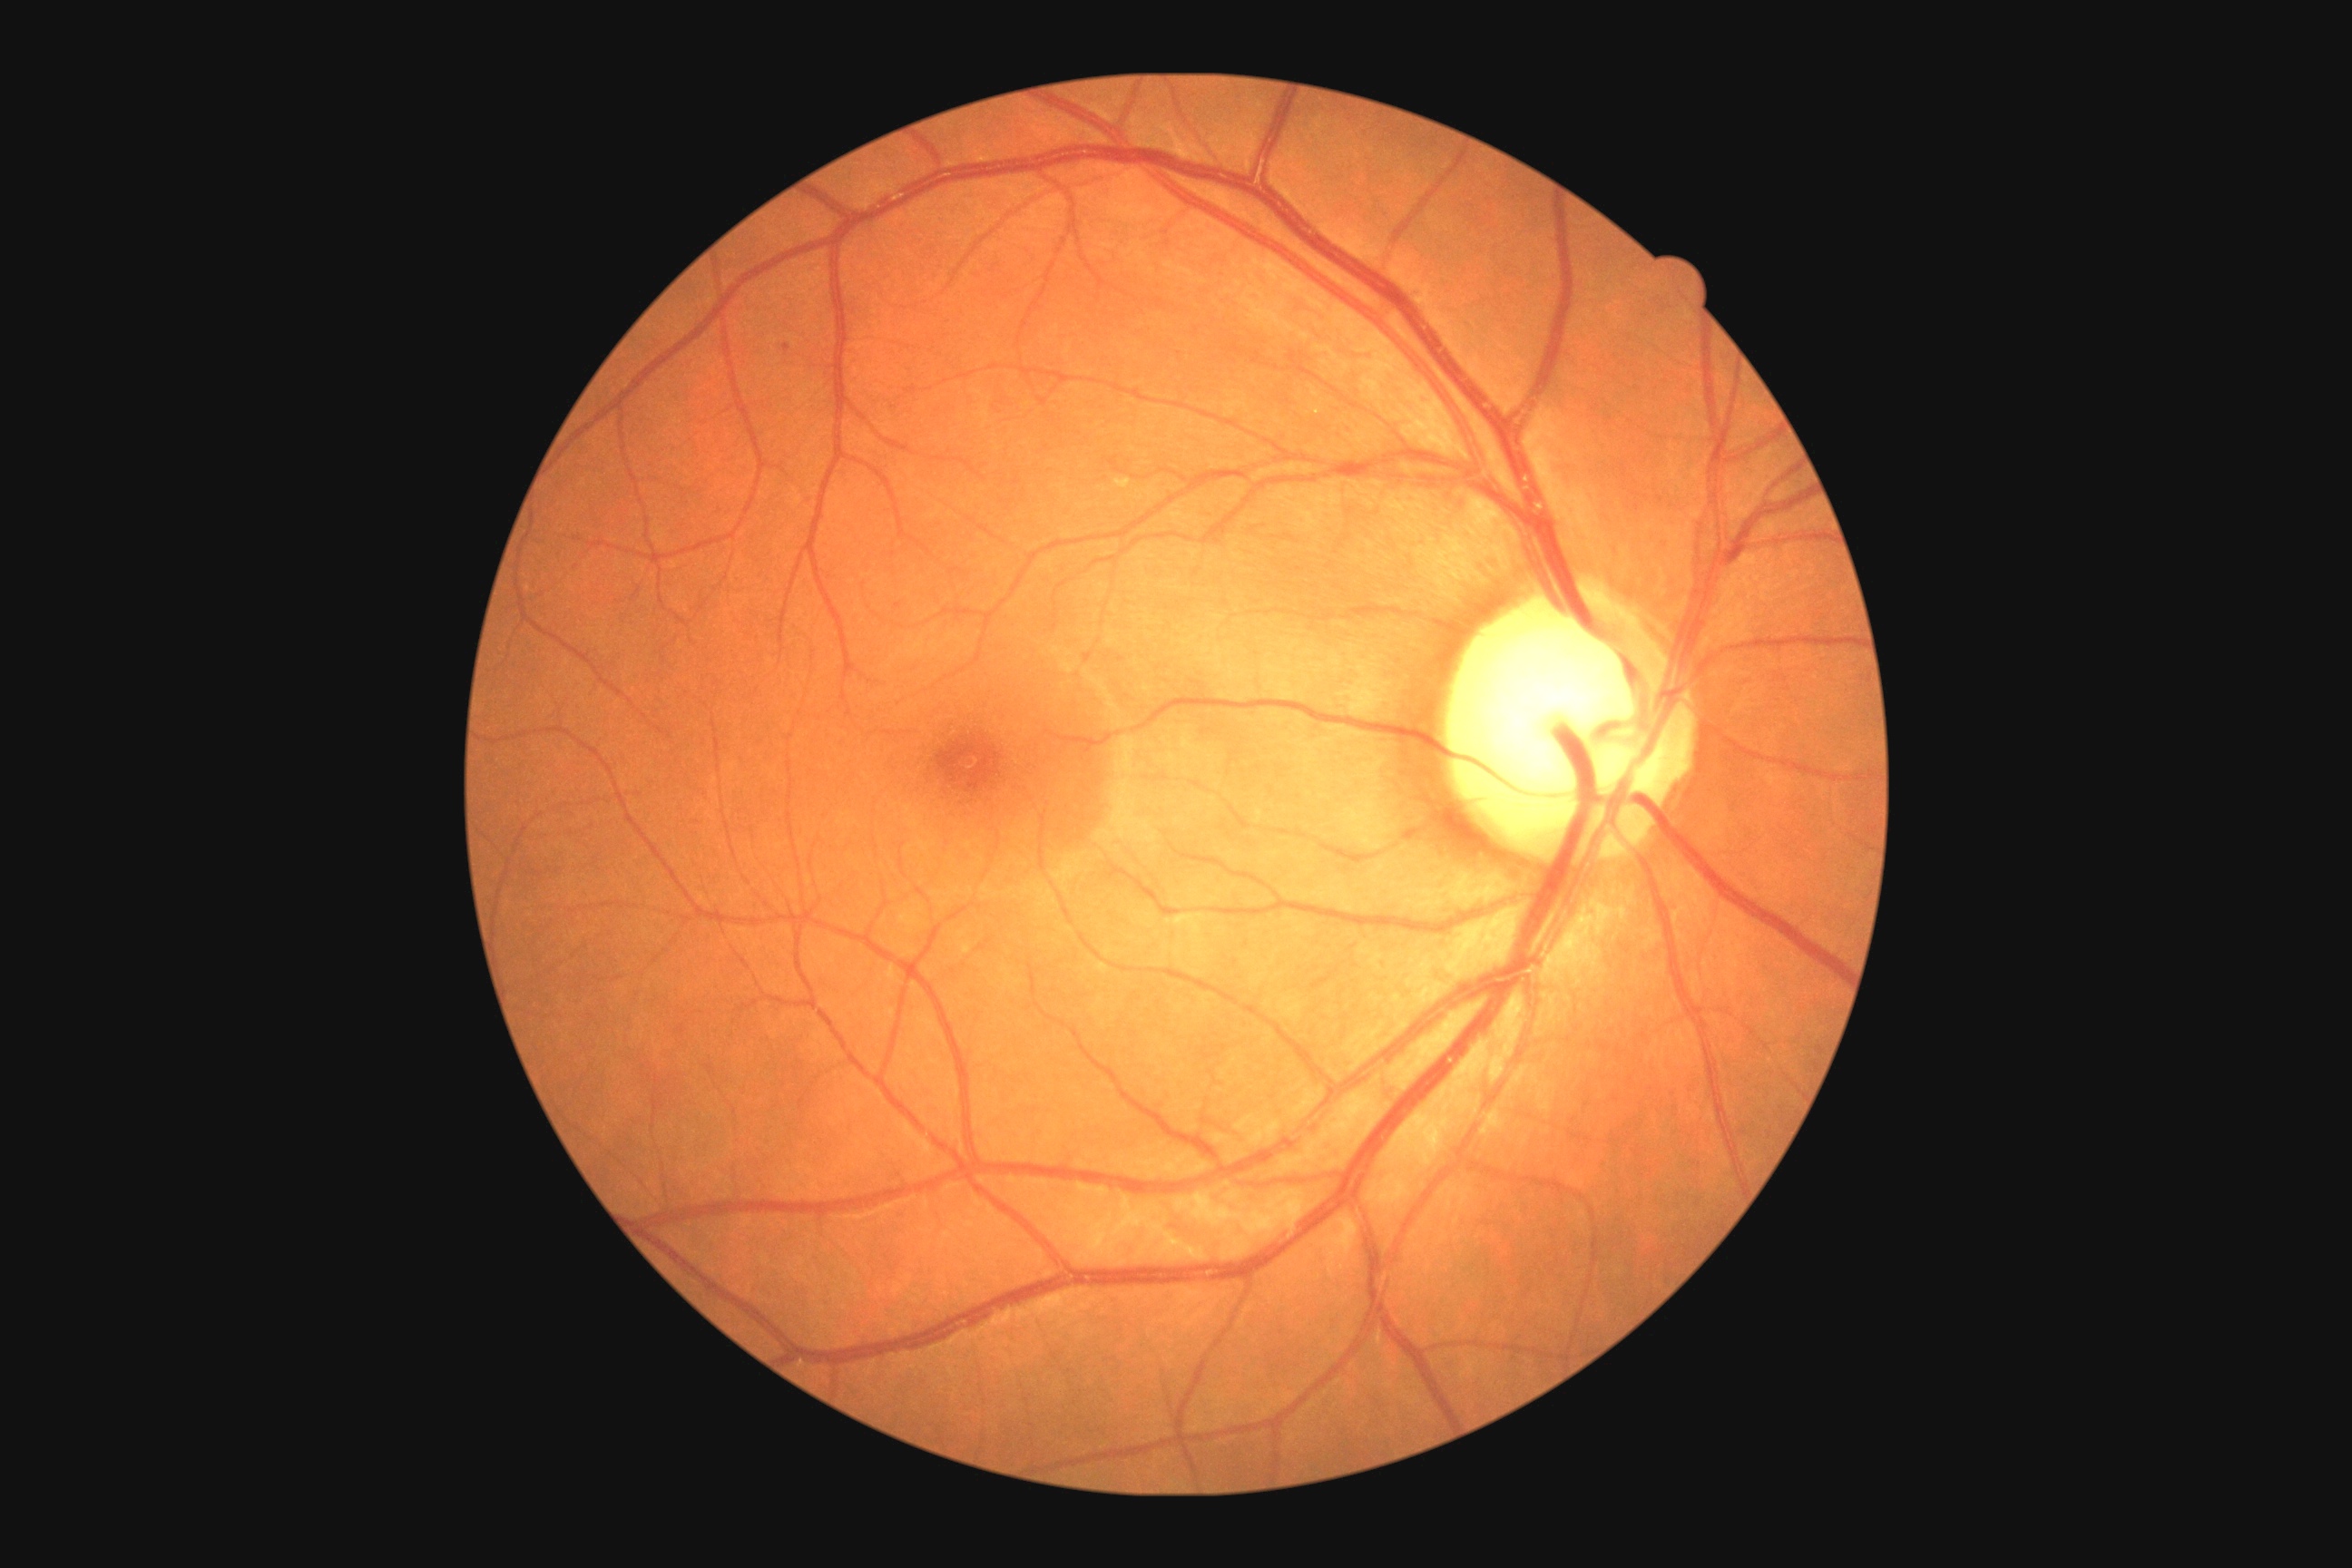
– diabetic retinopathy (DR): mild non-proliferative diabetic retinopathy (grade 1)